Image size 2352x1568 · fundus photo · 45-degree field of view
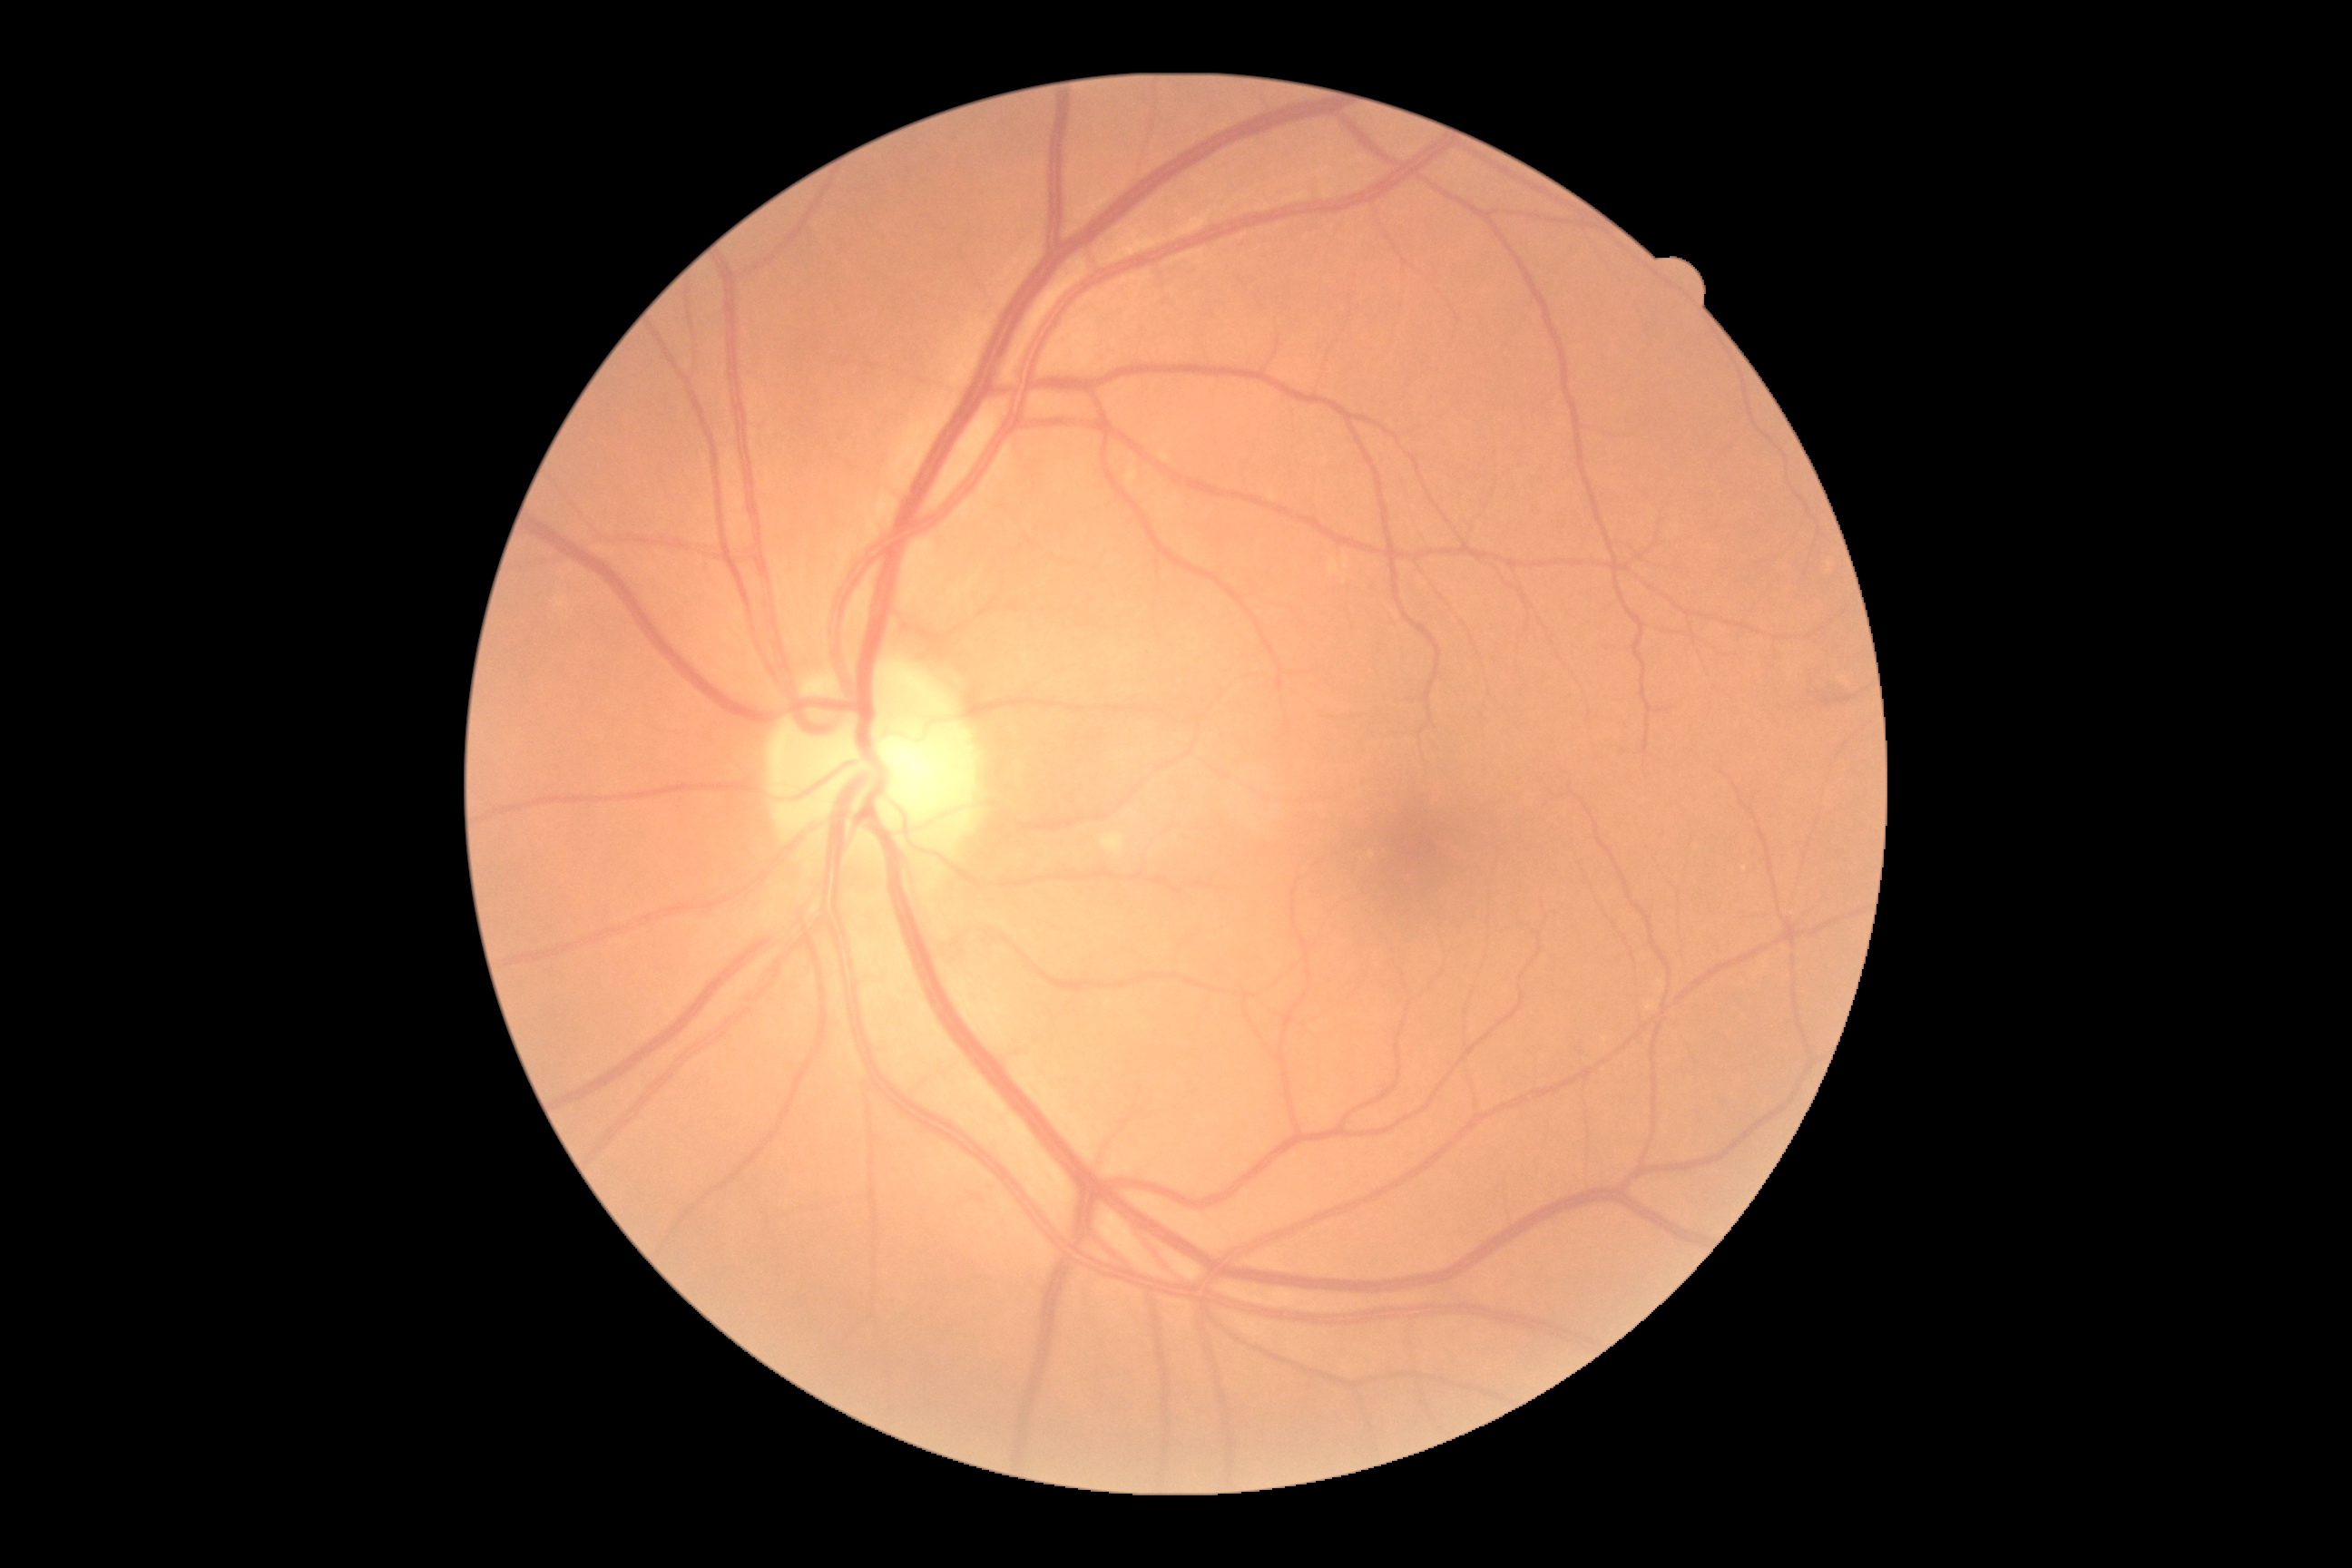 Diabetic retinopathy is no apparent diabetic retinopathy (grade 0).